Captured on a Topcon TRC retinal camera · optic disc region of a color fundus photo
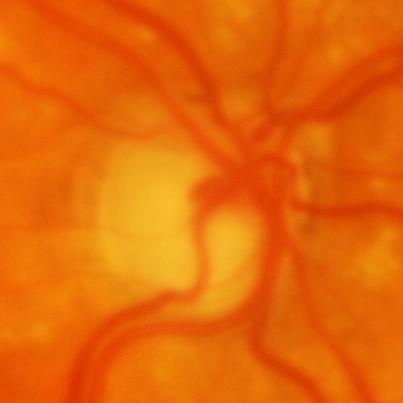

Impression: evidence of glaucoma.